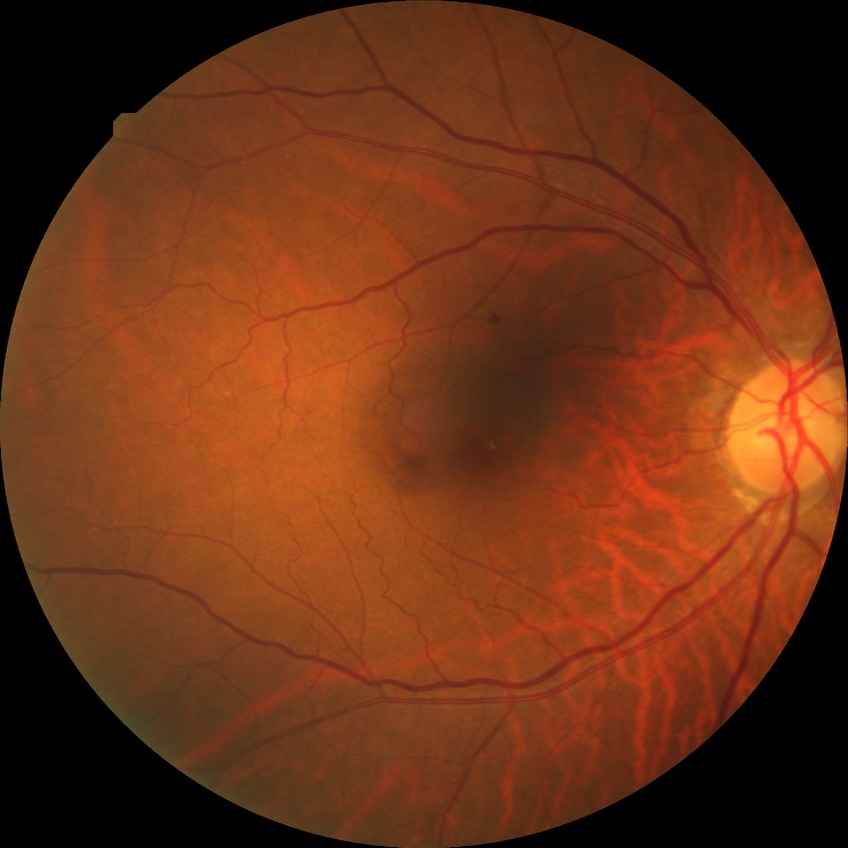 Findings:
* DR impression: negative for DR
* modified Davis grade: NDR